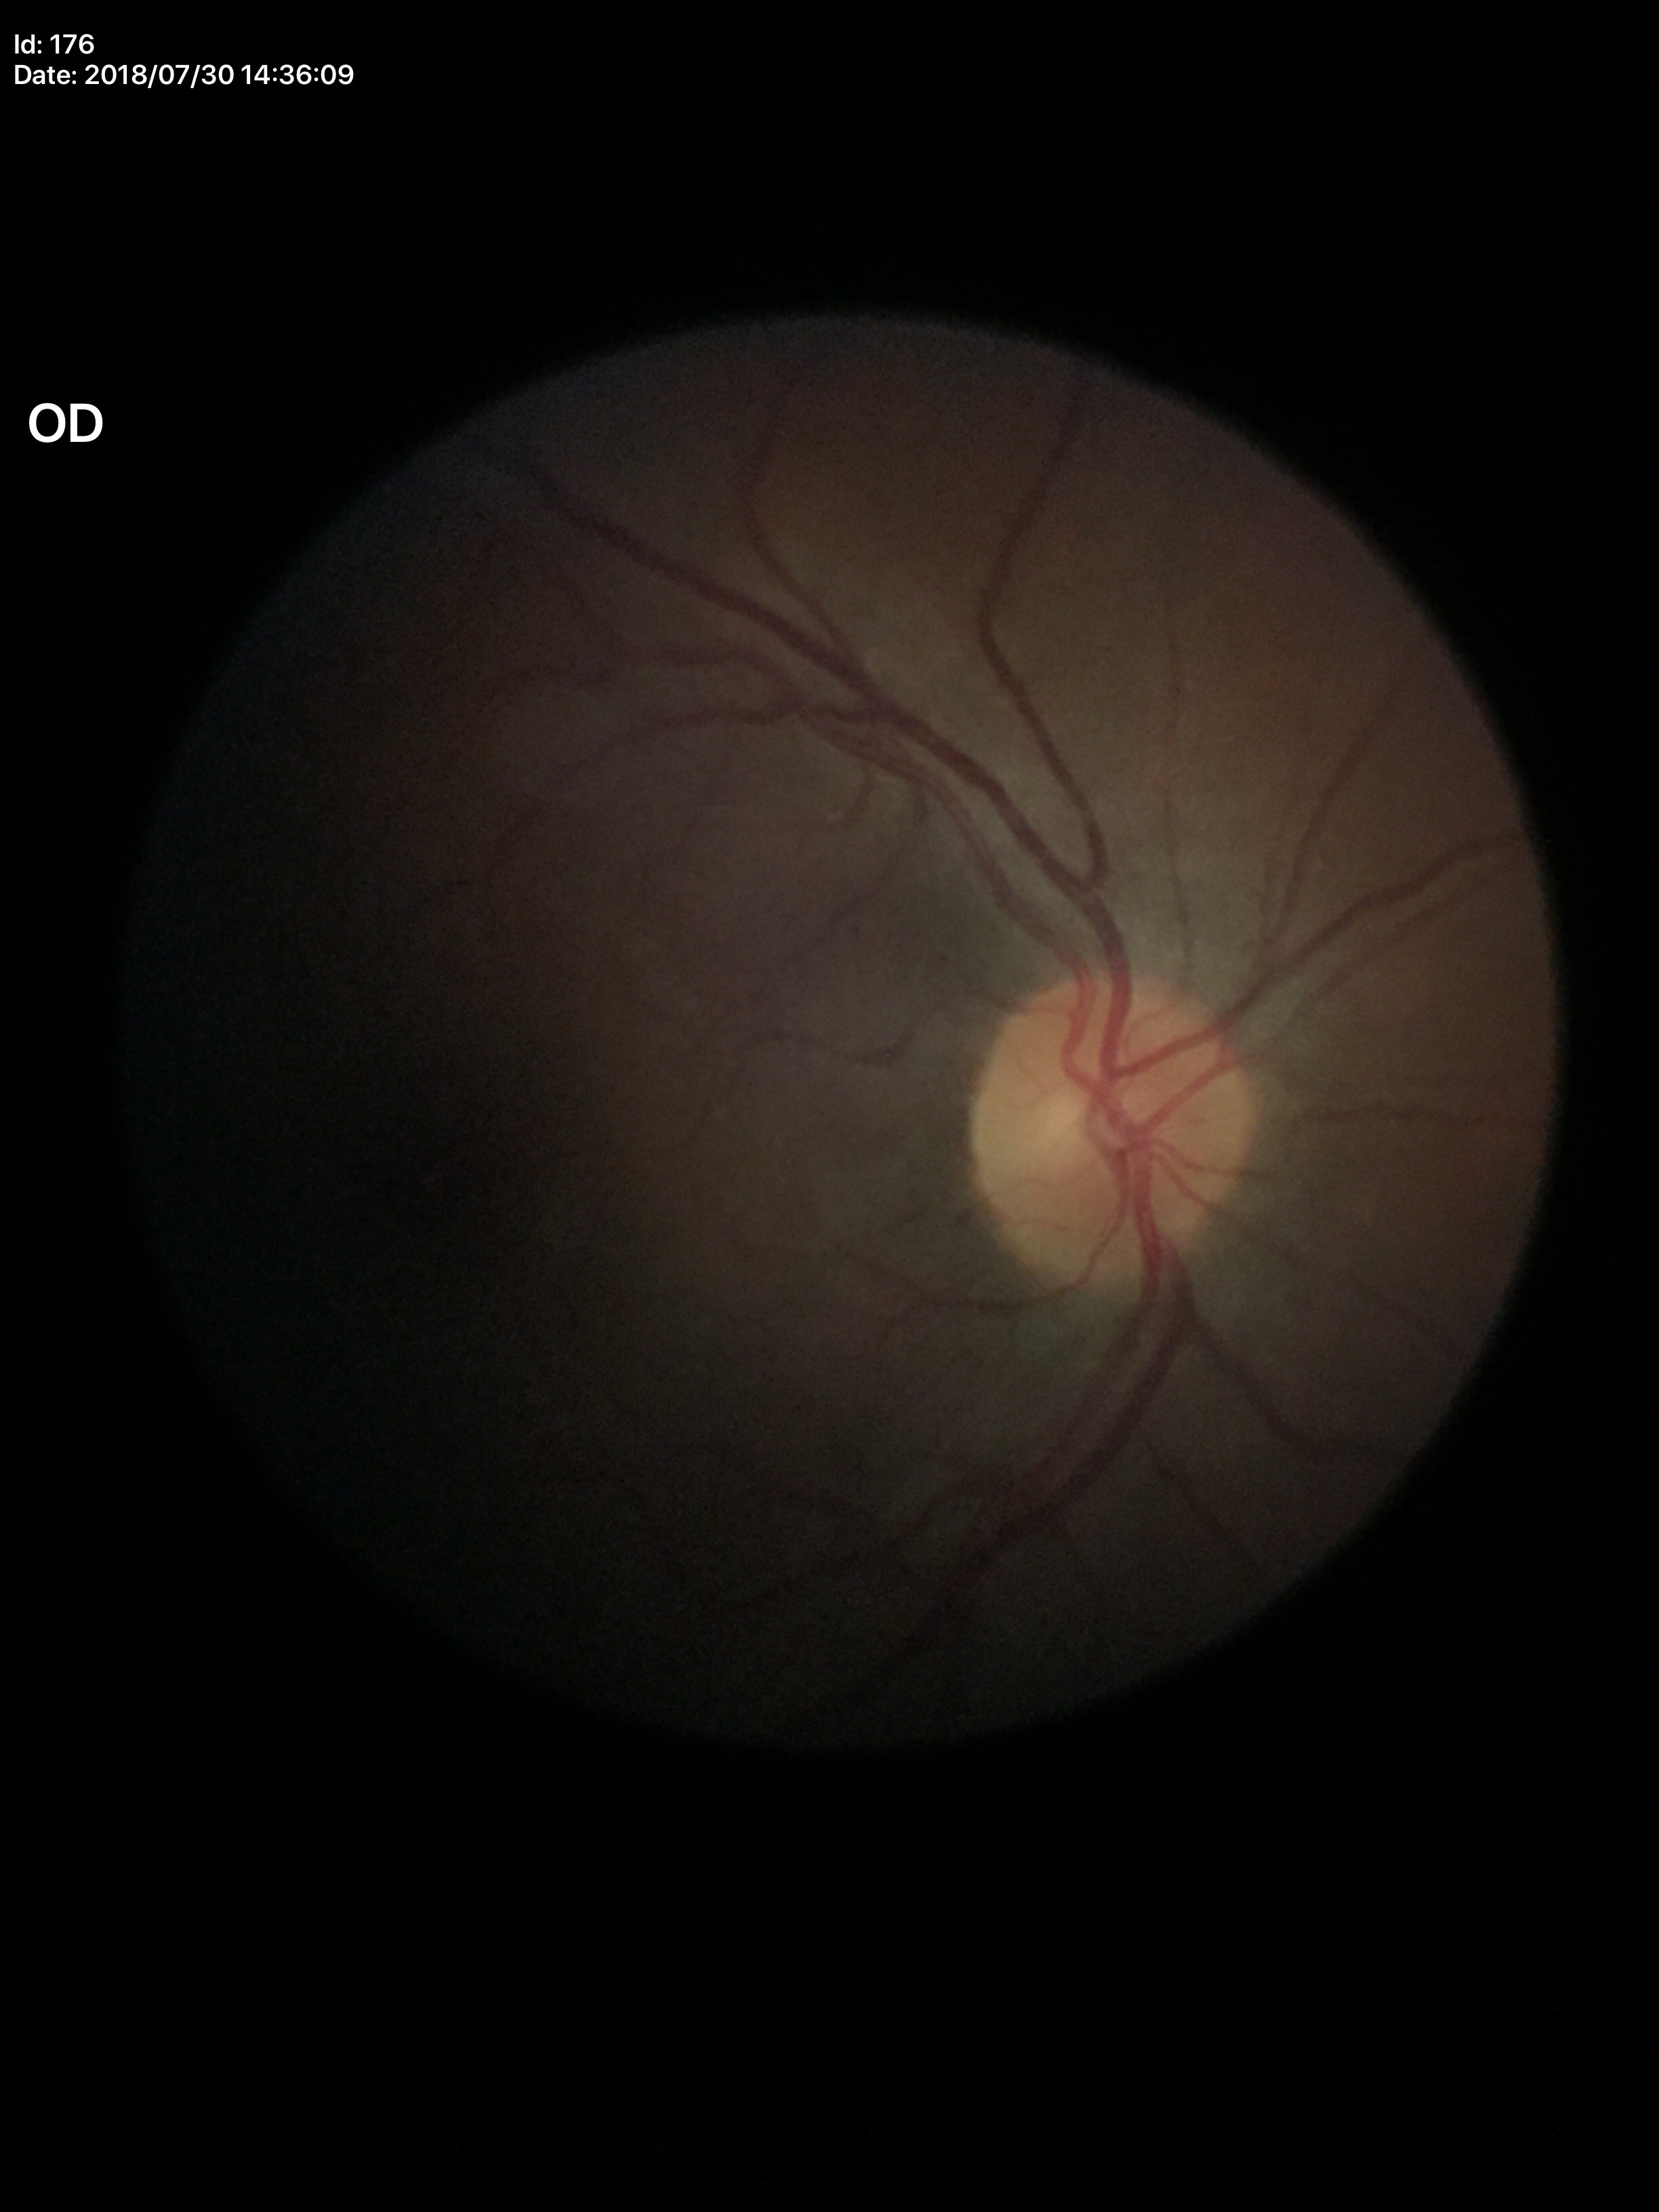 Glaucoma screening=negative | vertical C/D ratio=0.45